Color fundus photograph · modified Davis classification · no pharmacologic dilation:
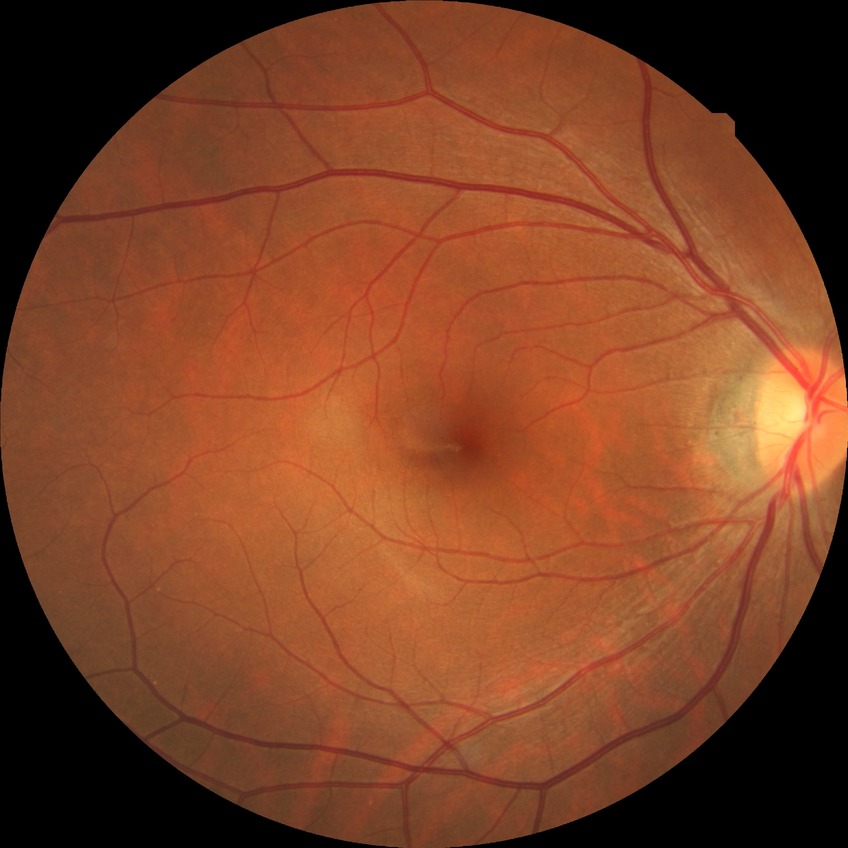
Retinopathy stage is no diabetic retinopathy.